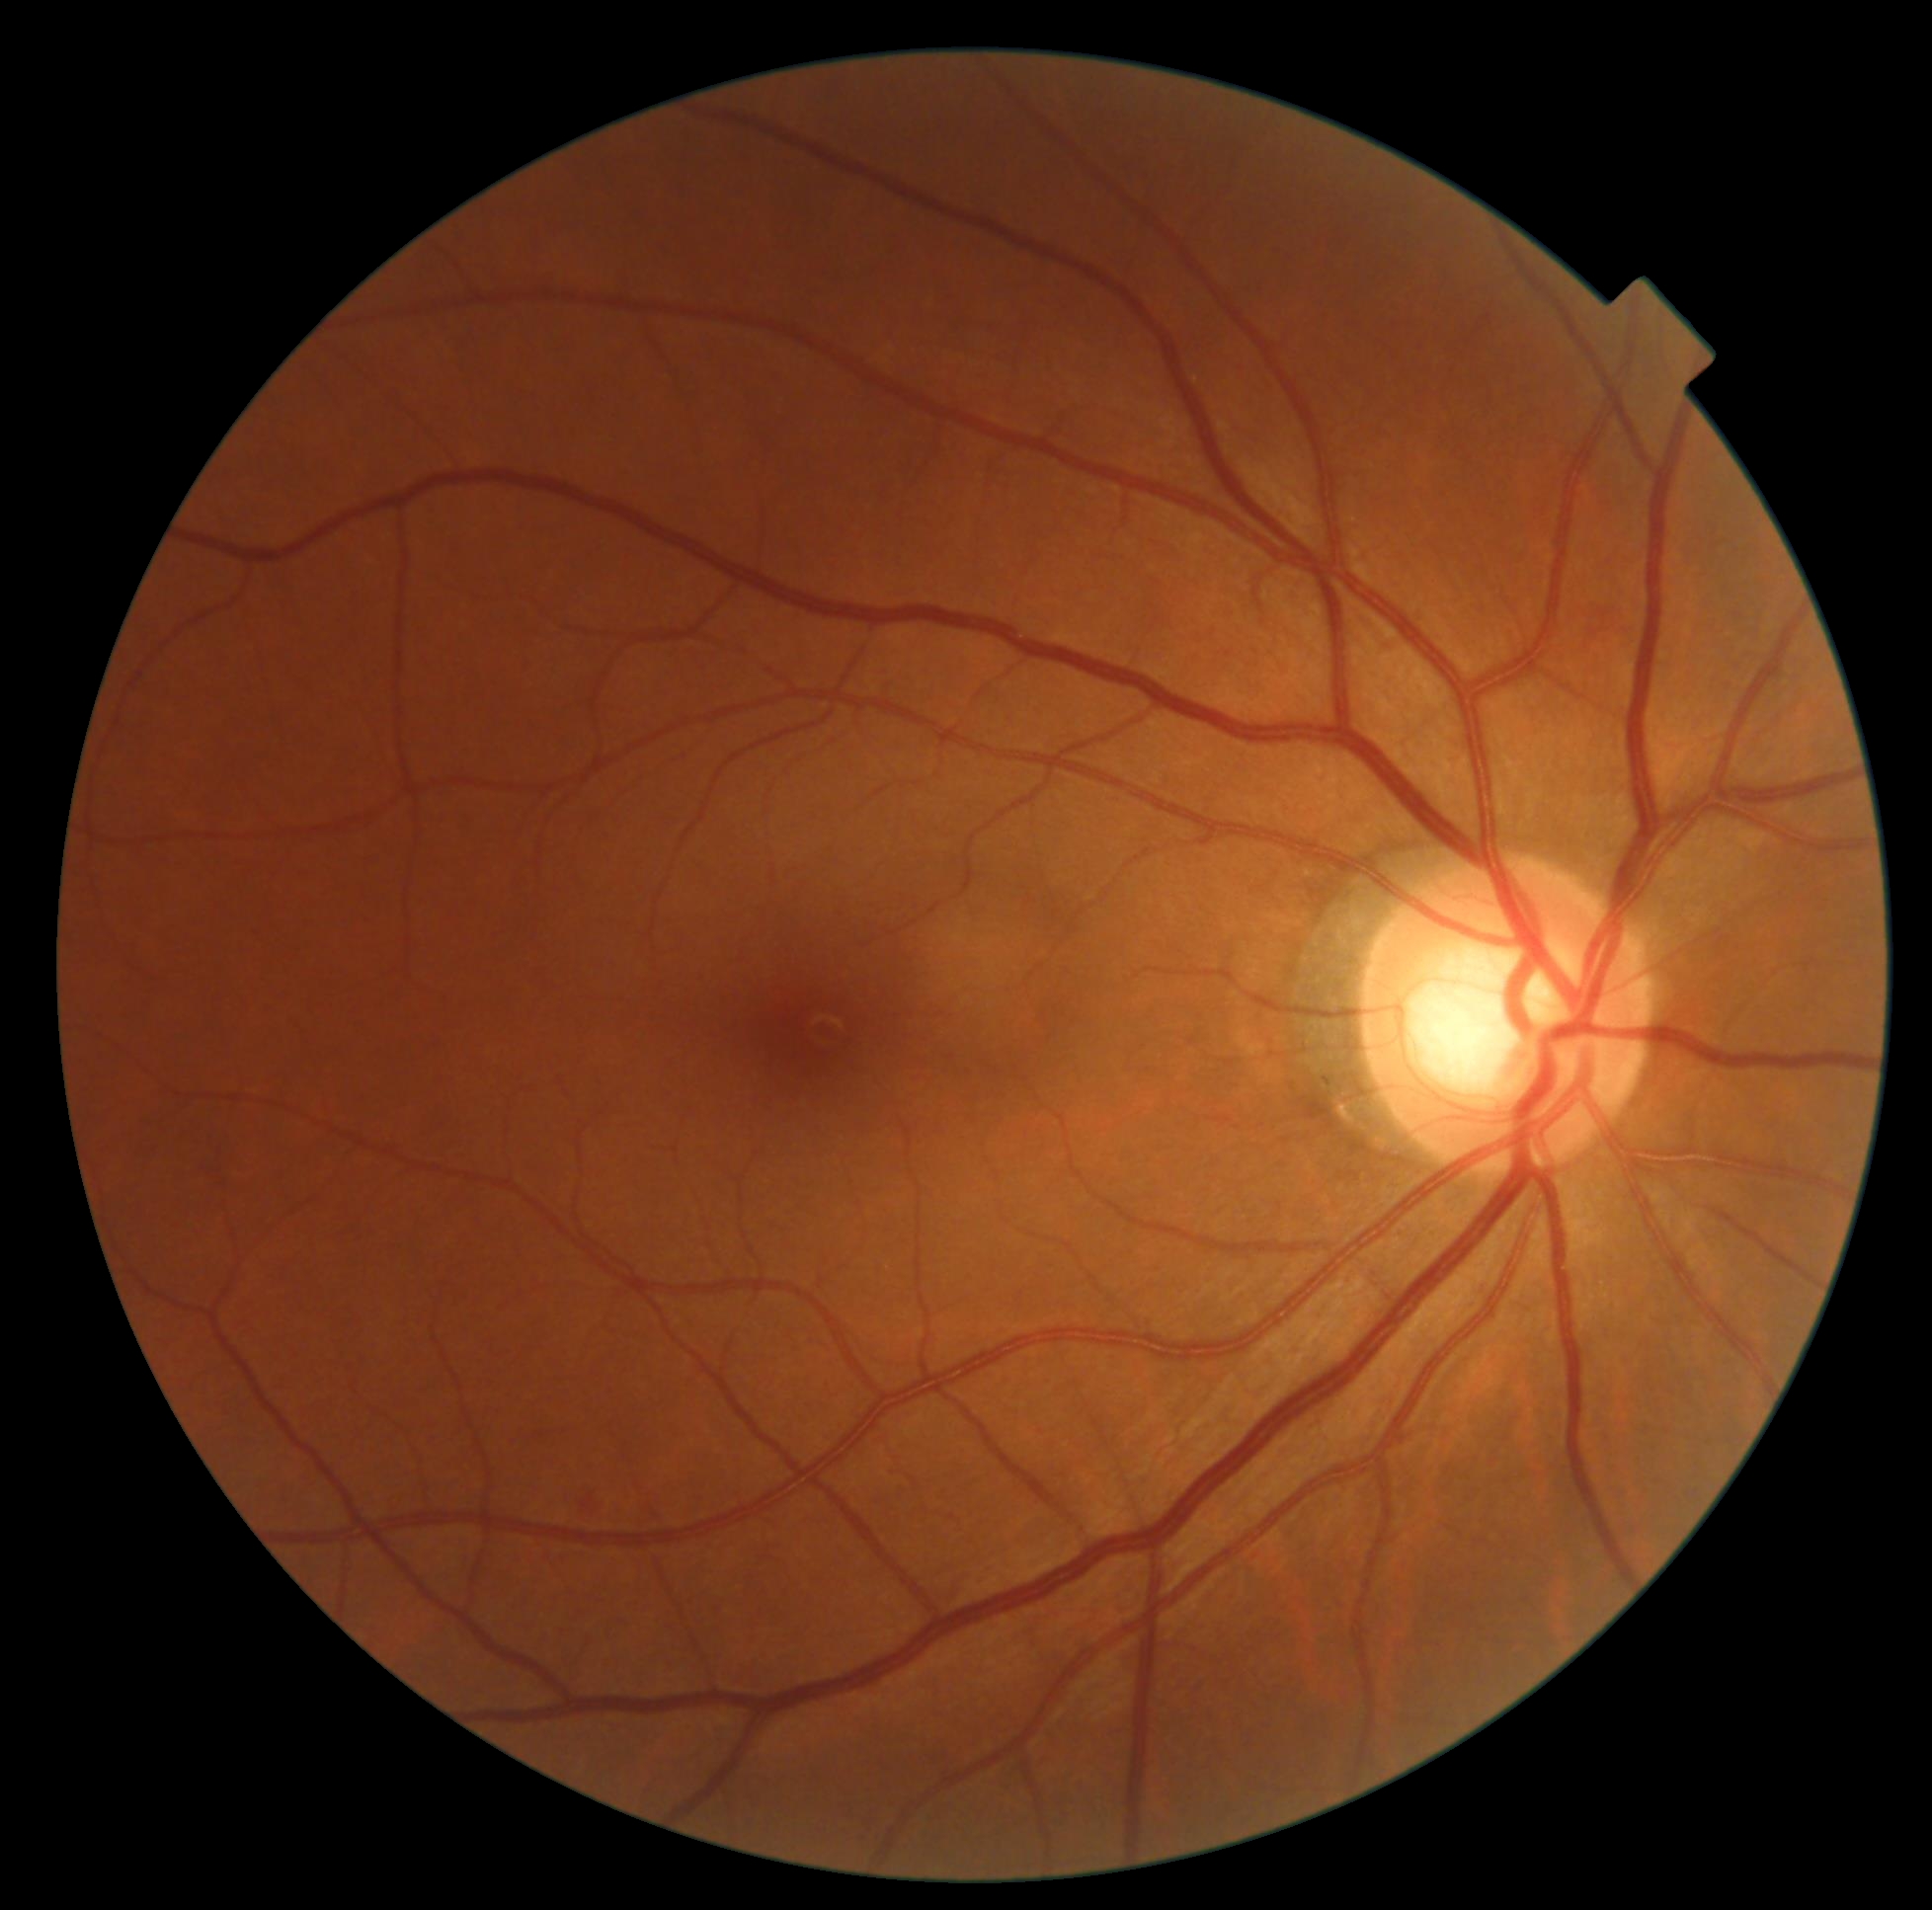
DR grade: moderate NPDR (2) — more than just microaneurysms but less than severe NPDR.